848x848 · without pupil dilation · fundus photo · NIDEK AFC-230 fundus camera · 45° FOV.
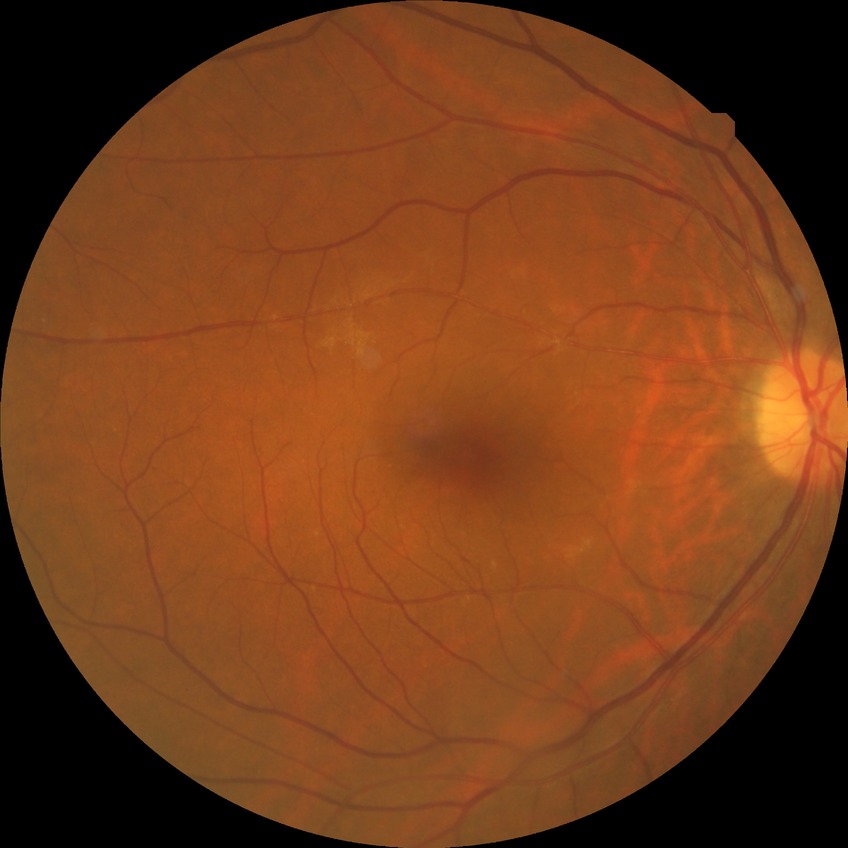
{
  "davis_grade": "no diabetic retinopathy"
}